Color fundus image · modified Davis classification — 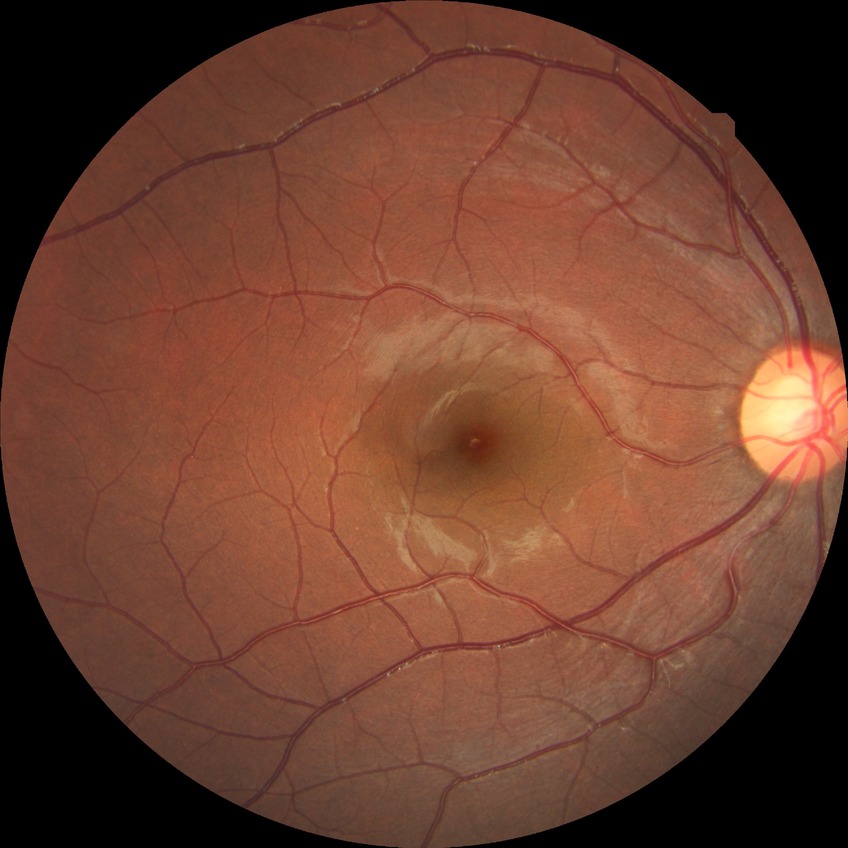

Diabetic retinopathy (DR) is NDR (no diabetic retinopathy).